Phoenix ICON wide-field infant fundus image; 1240x1240px: 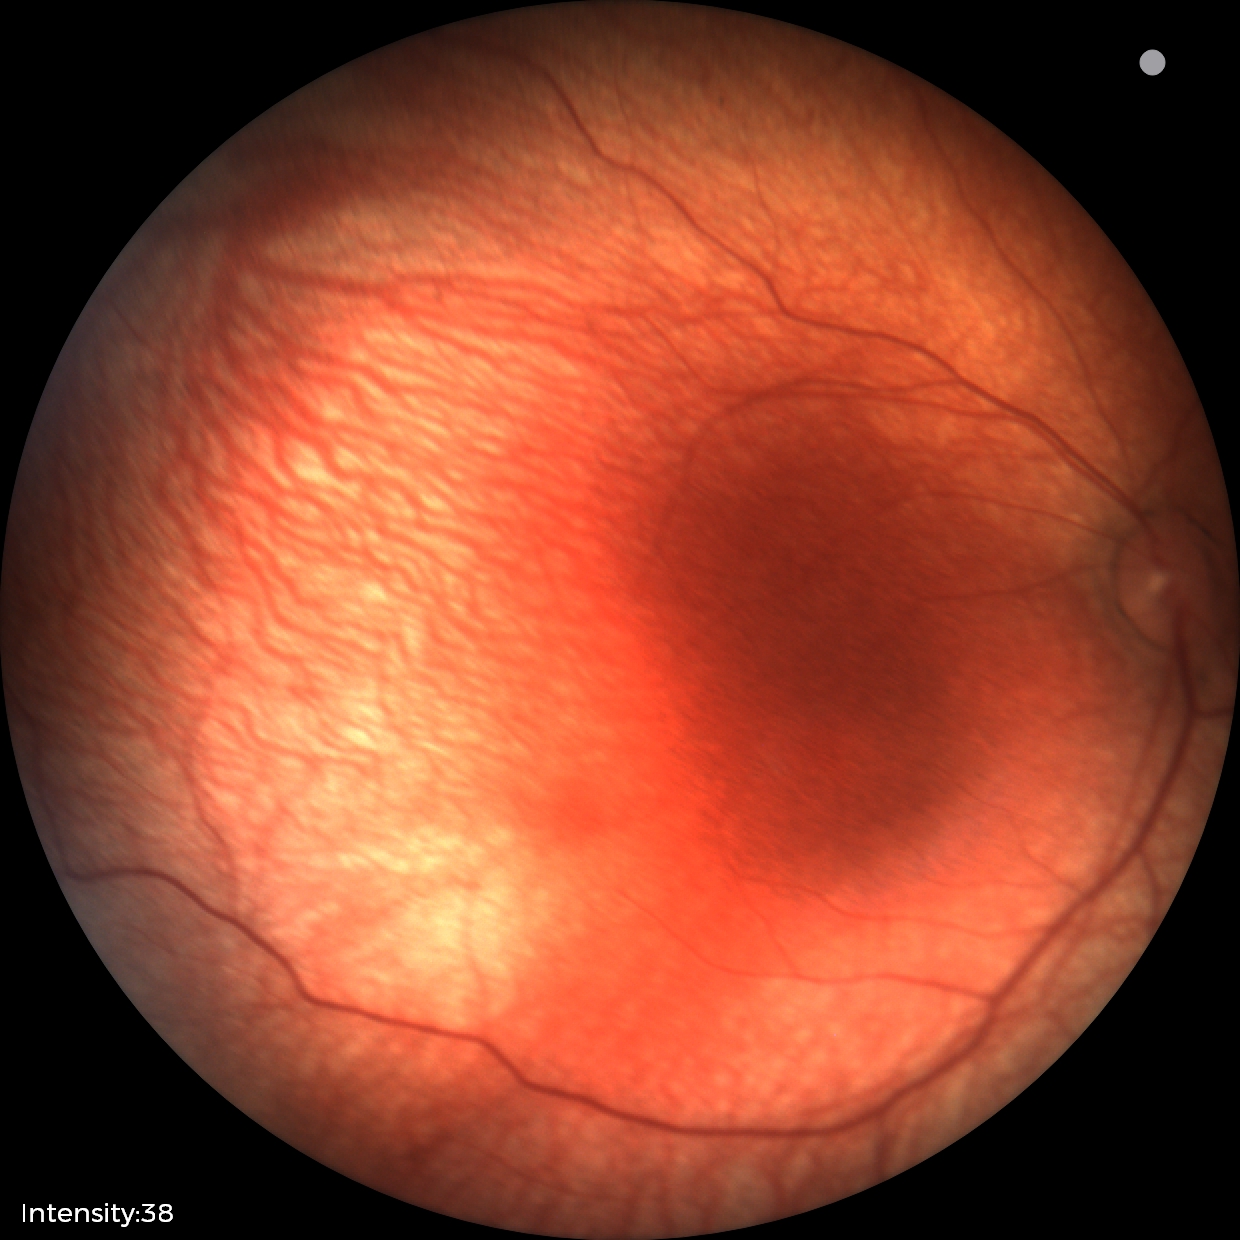

Impression = no pathology identified.